45-degree field of view; CFP; 848x848; Davis DR grading; NIDEK AFC-230 fundus camera — 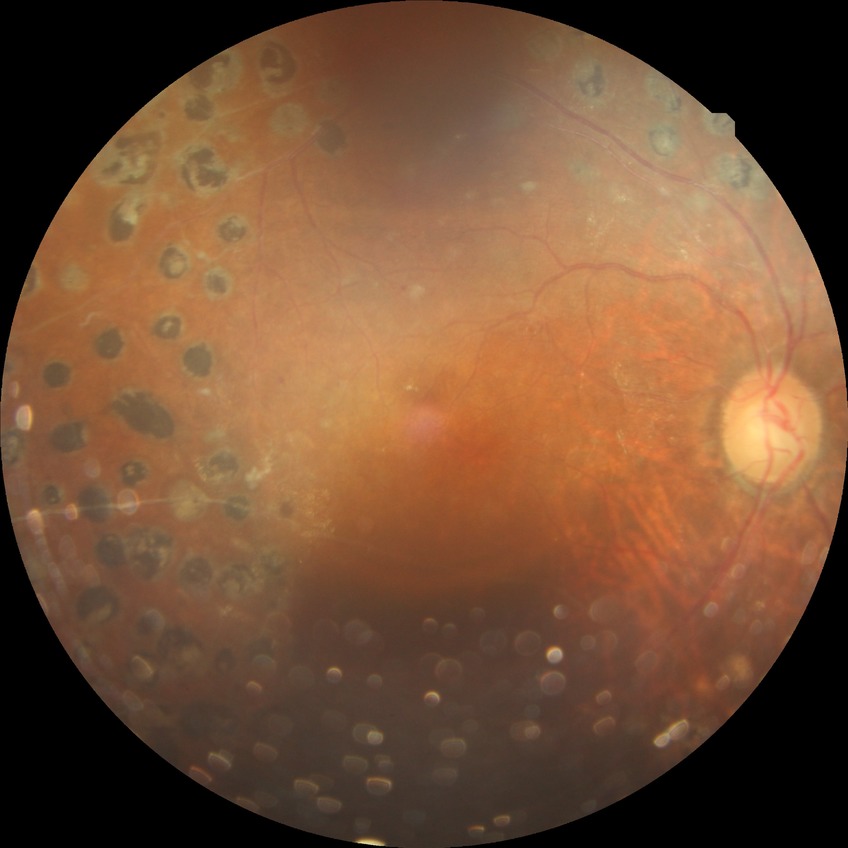
{"davis_grade": "PDR (proliferative diabetic retinopathy)"}